NIDEK AFC-230 fundus camera. Retinal fundus photograph. 848 x 848 pixels. 45-degree field of view
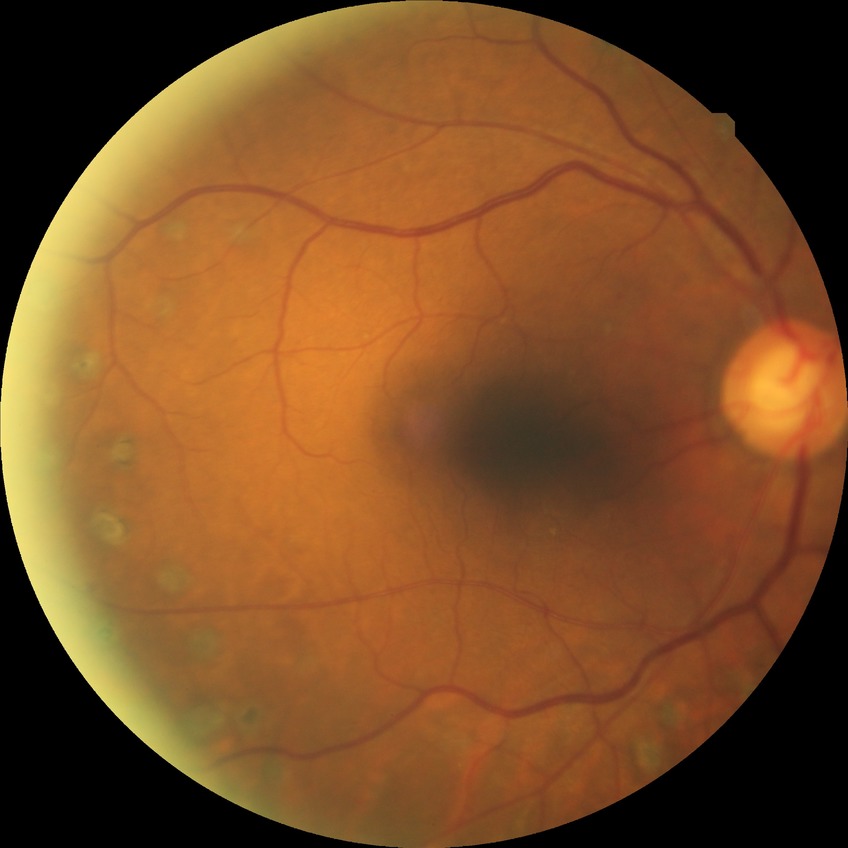
Modified Davis grading: proliferative diabetic retinopathy.